Graded on the modified Davis scale.
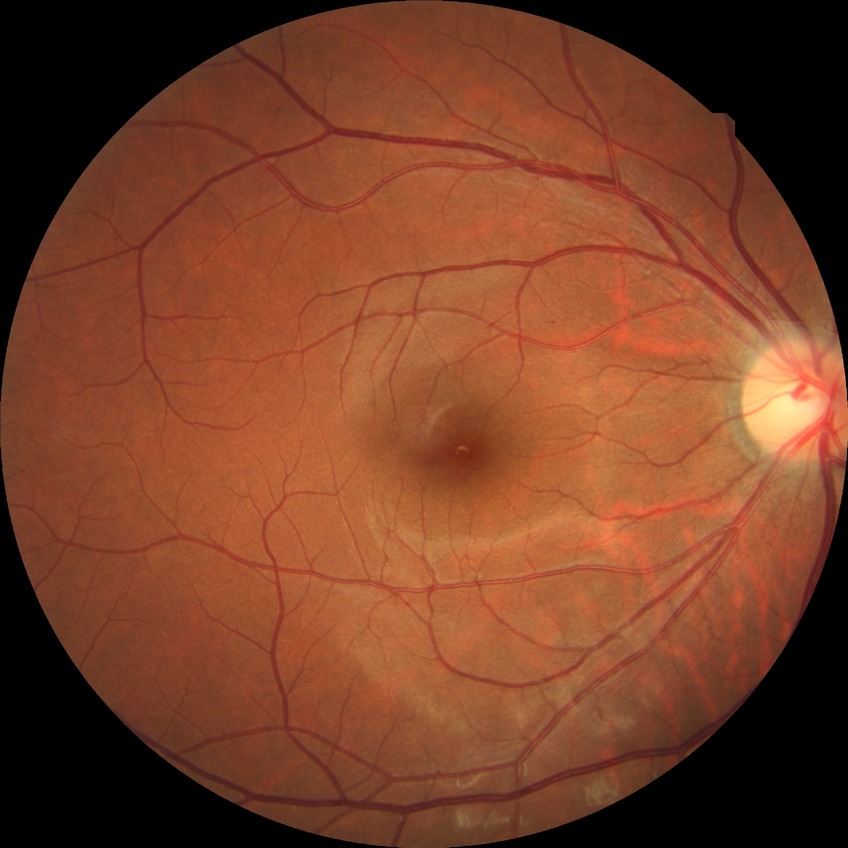
Diabetic retinopathy grade: no diabetic retinopathy.